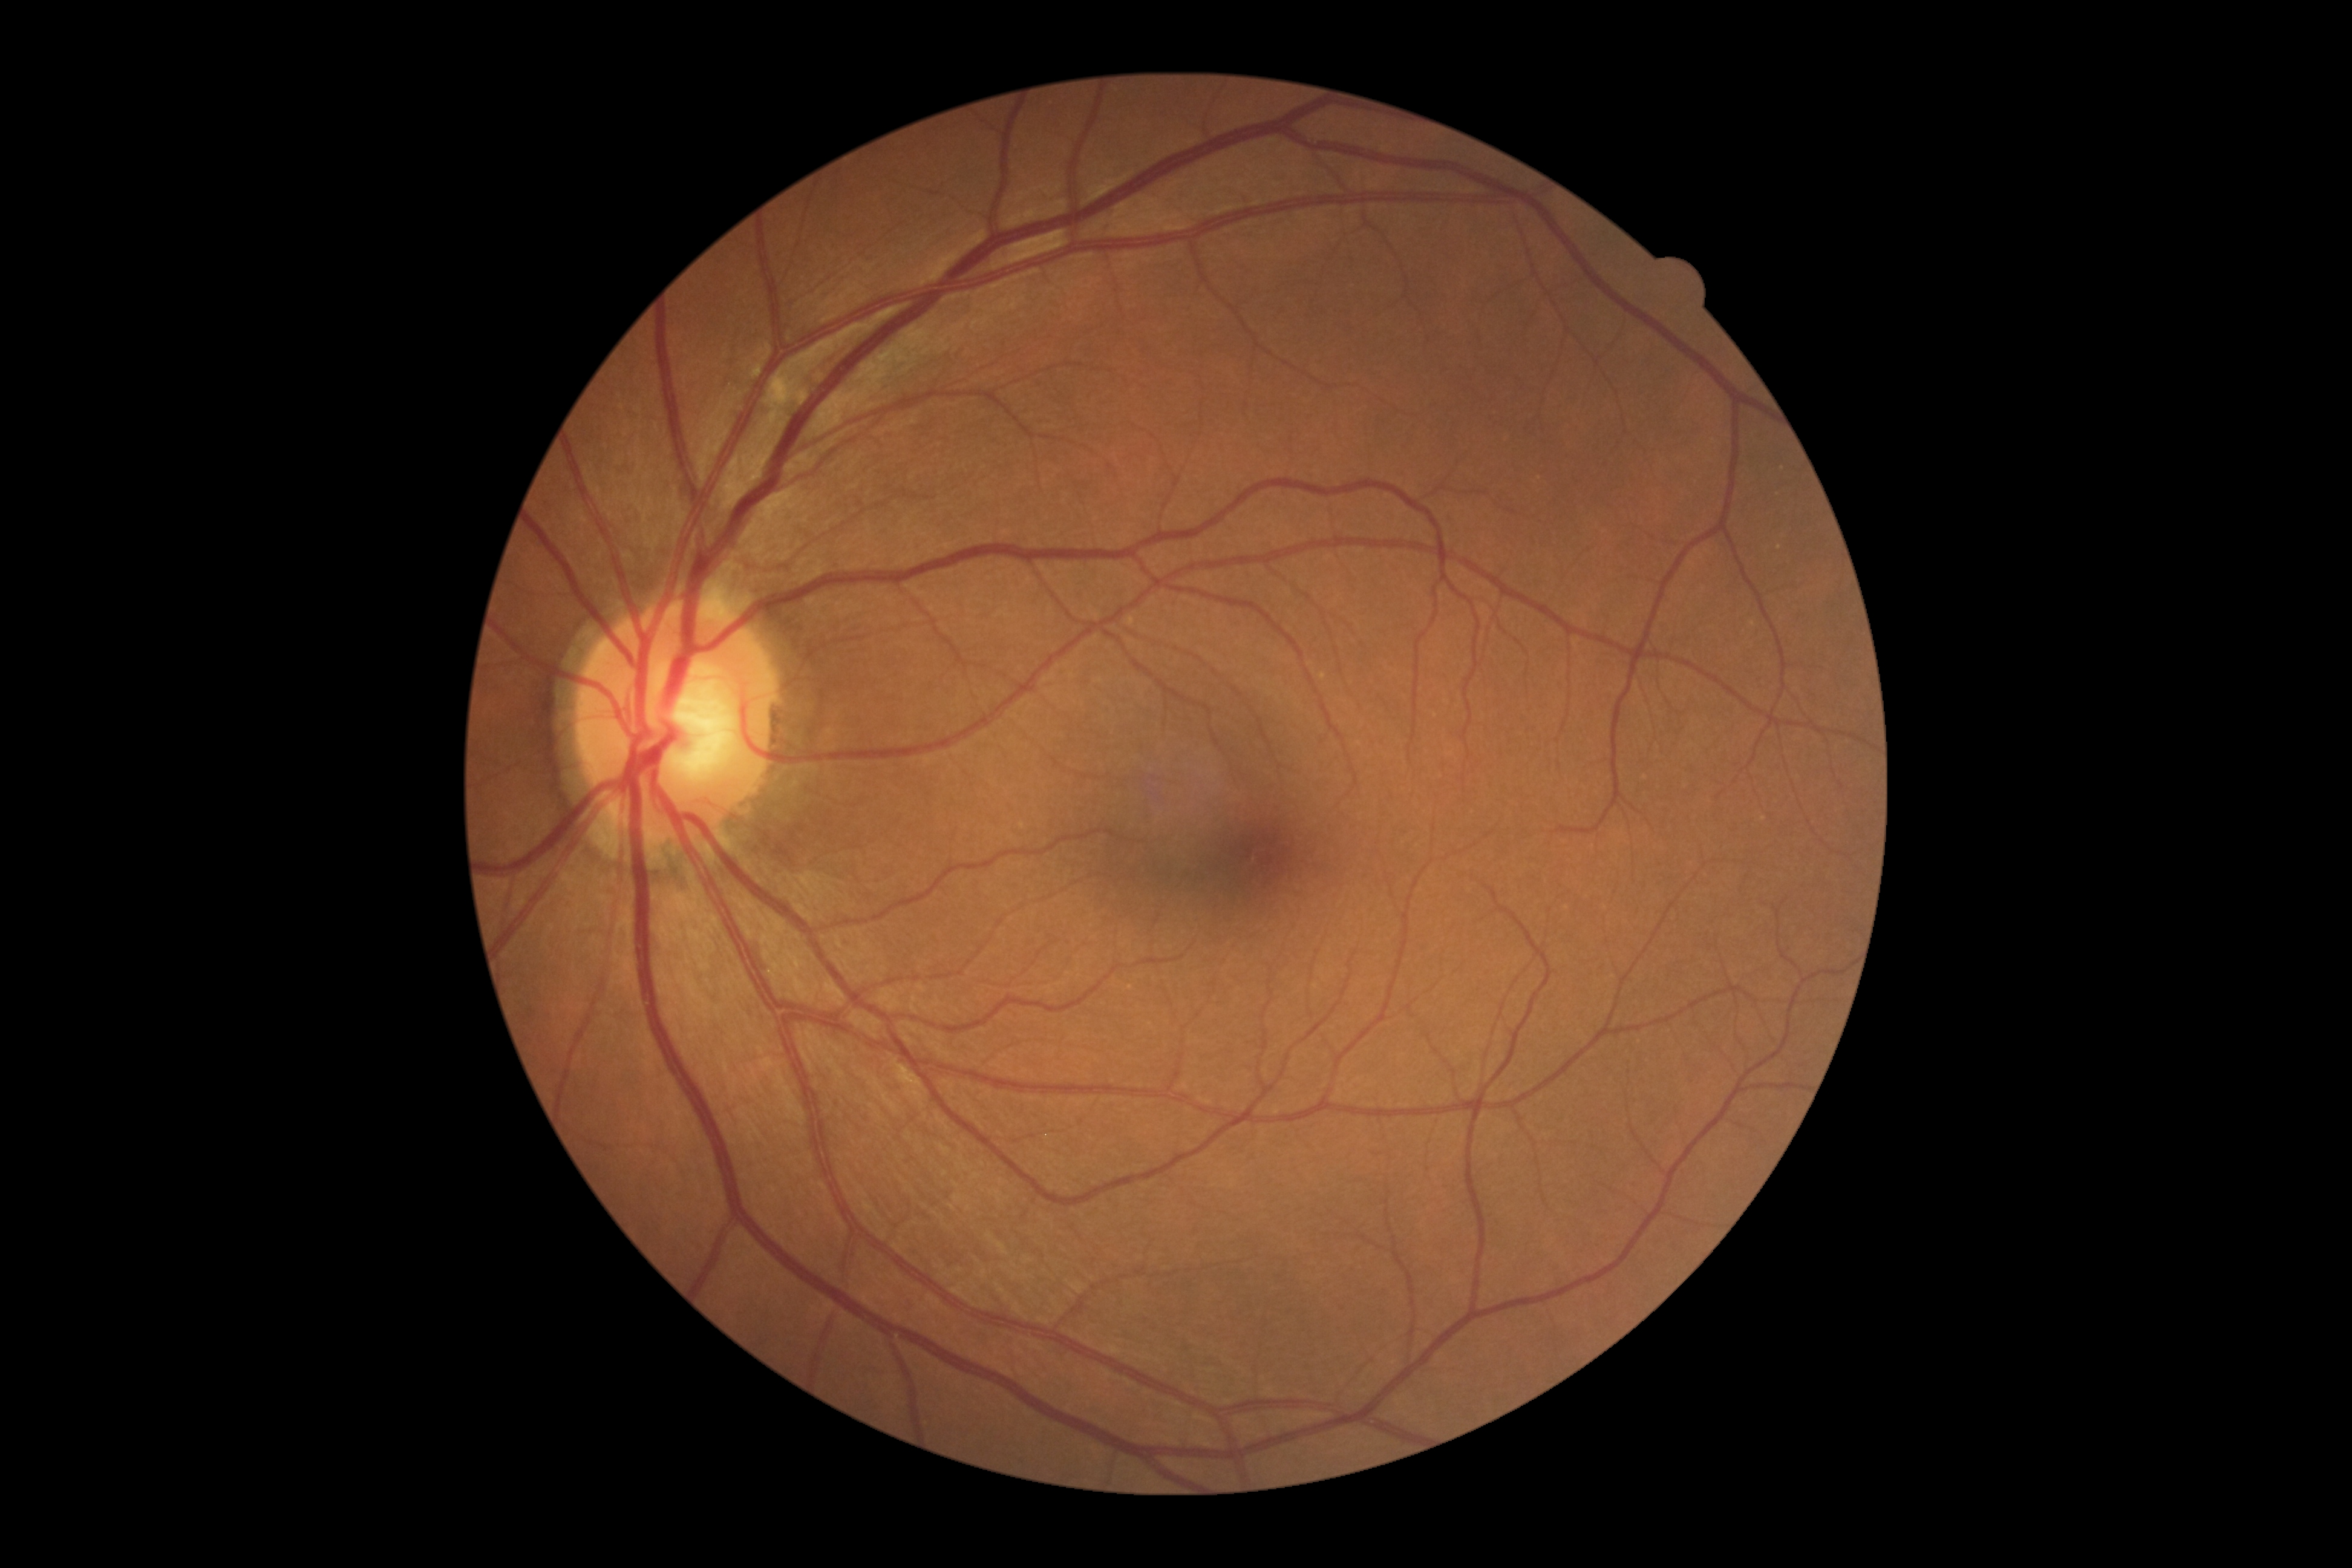 Diabetic retinopathy severity is no apparent retinopathy (grade 0).